Color fundus photograph; 45 degree fundus photograph
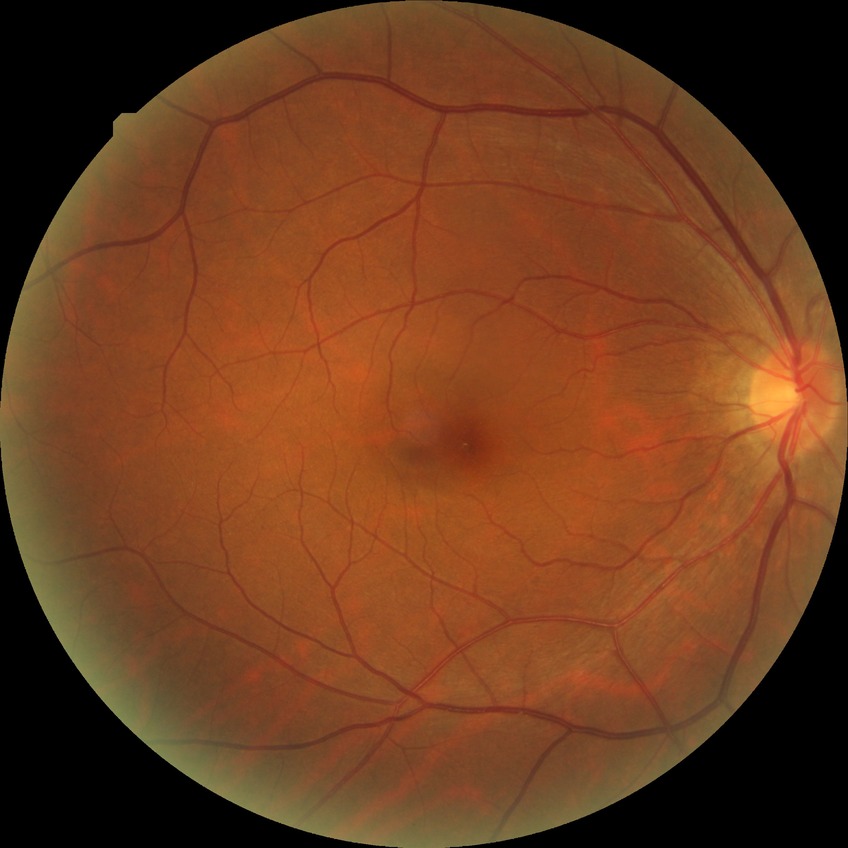 Diabetic retinopathy stage is no diabetic retinopathy.